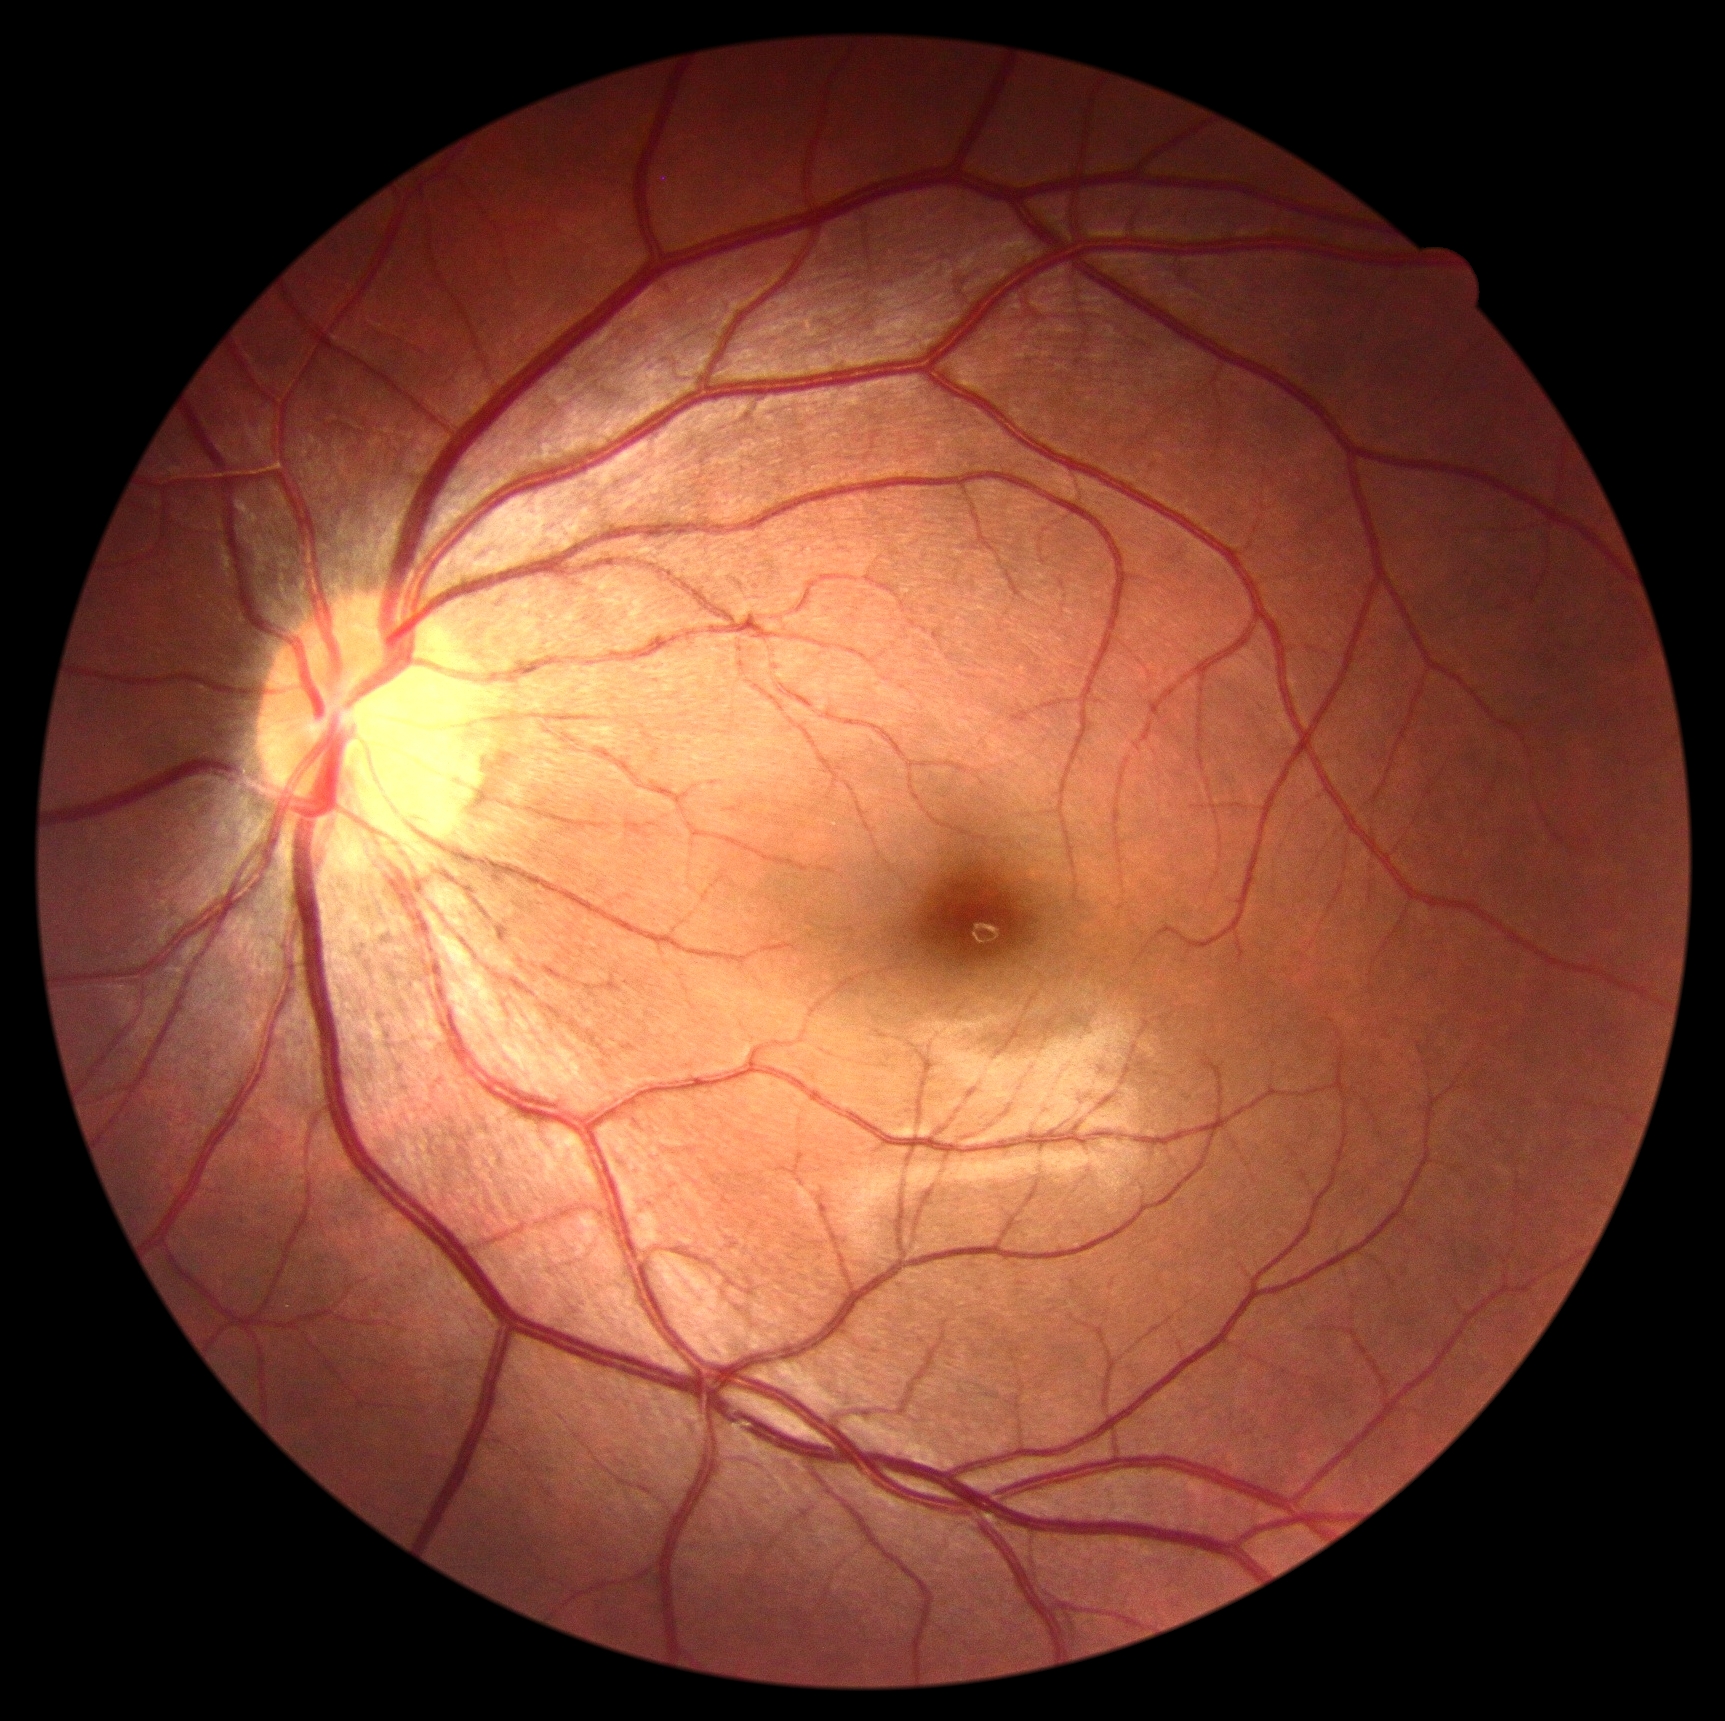

Diabetic retinopathy severity is grade 0 (no apparent retinopathy).